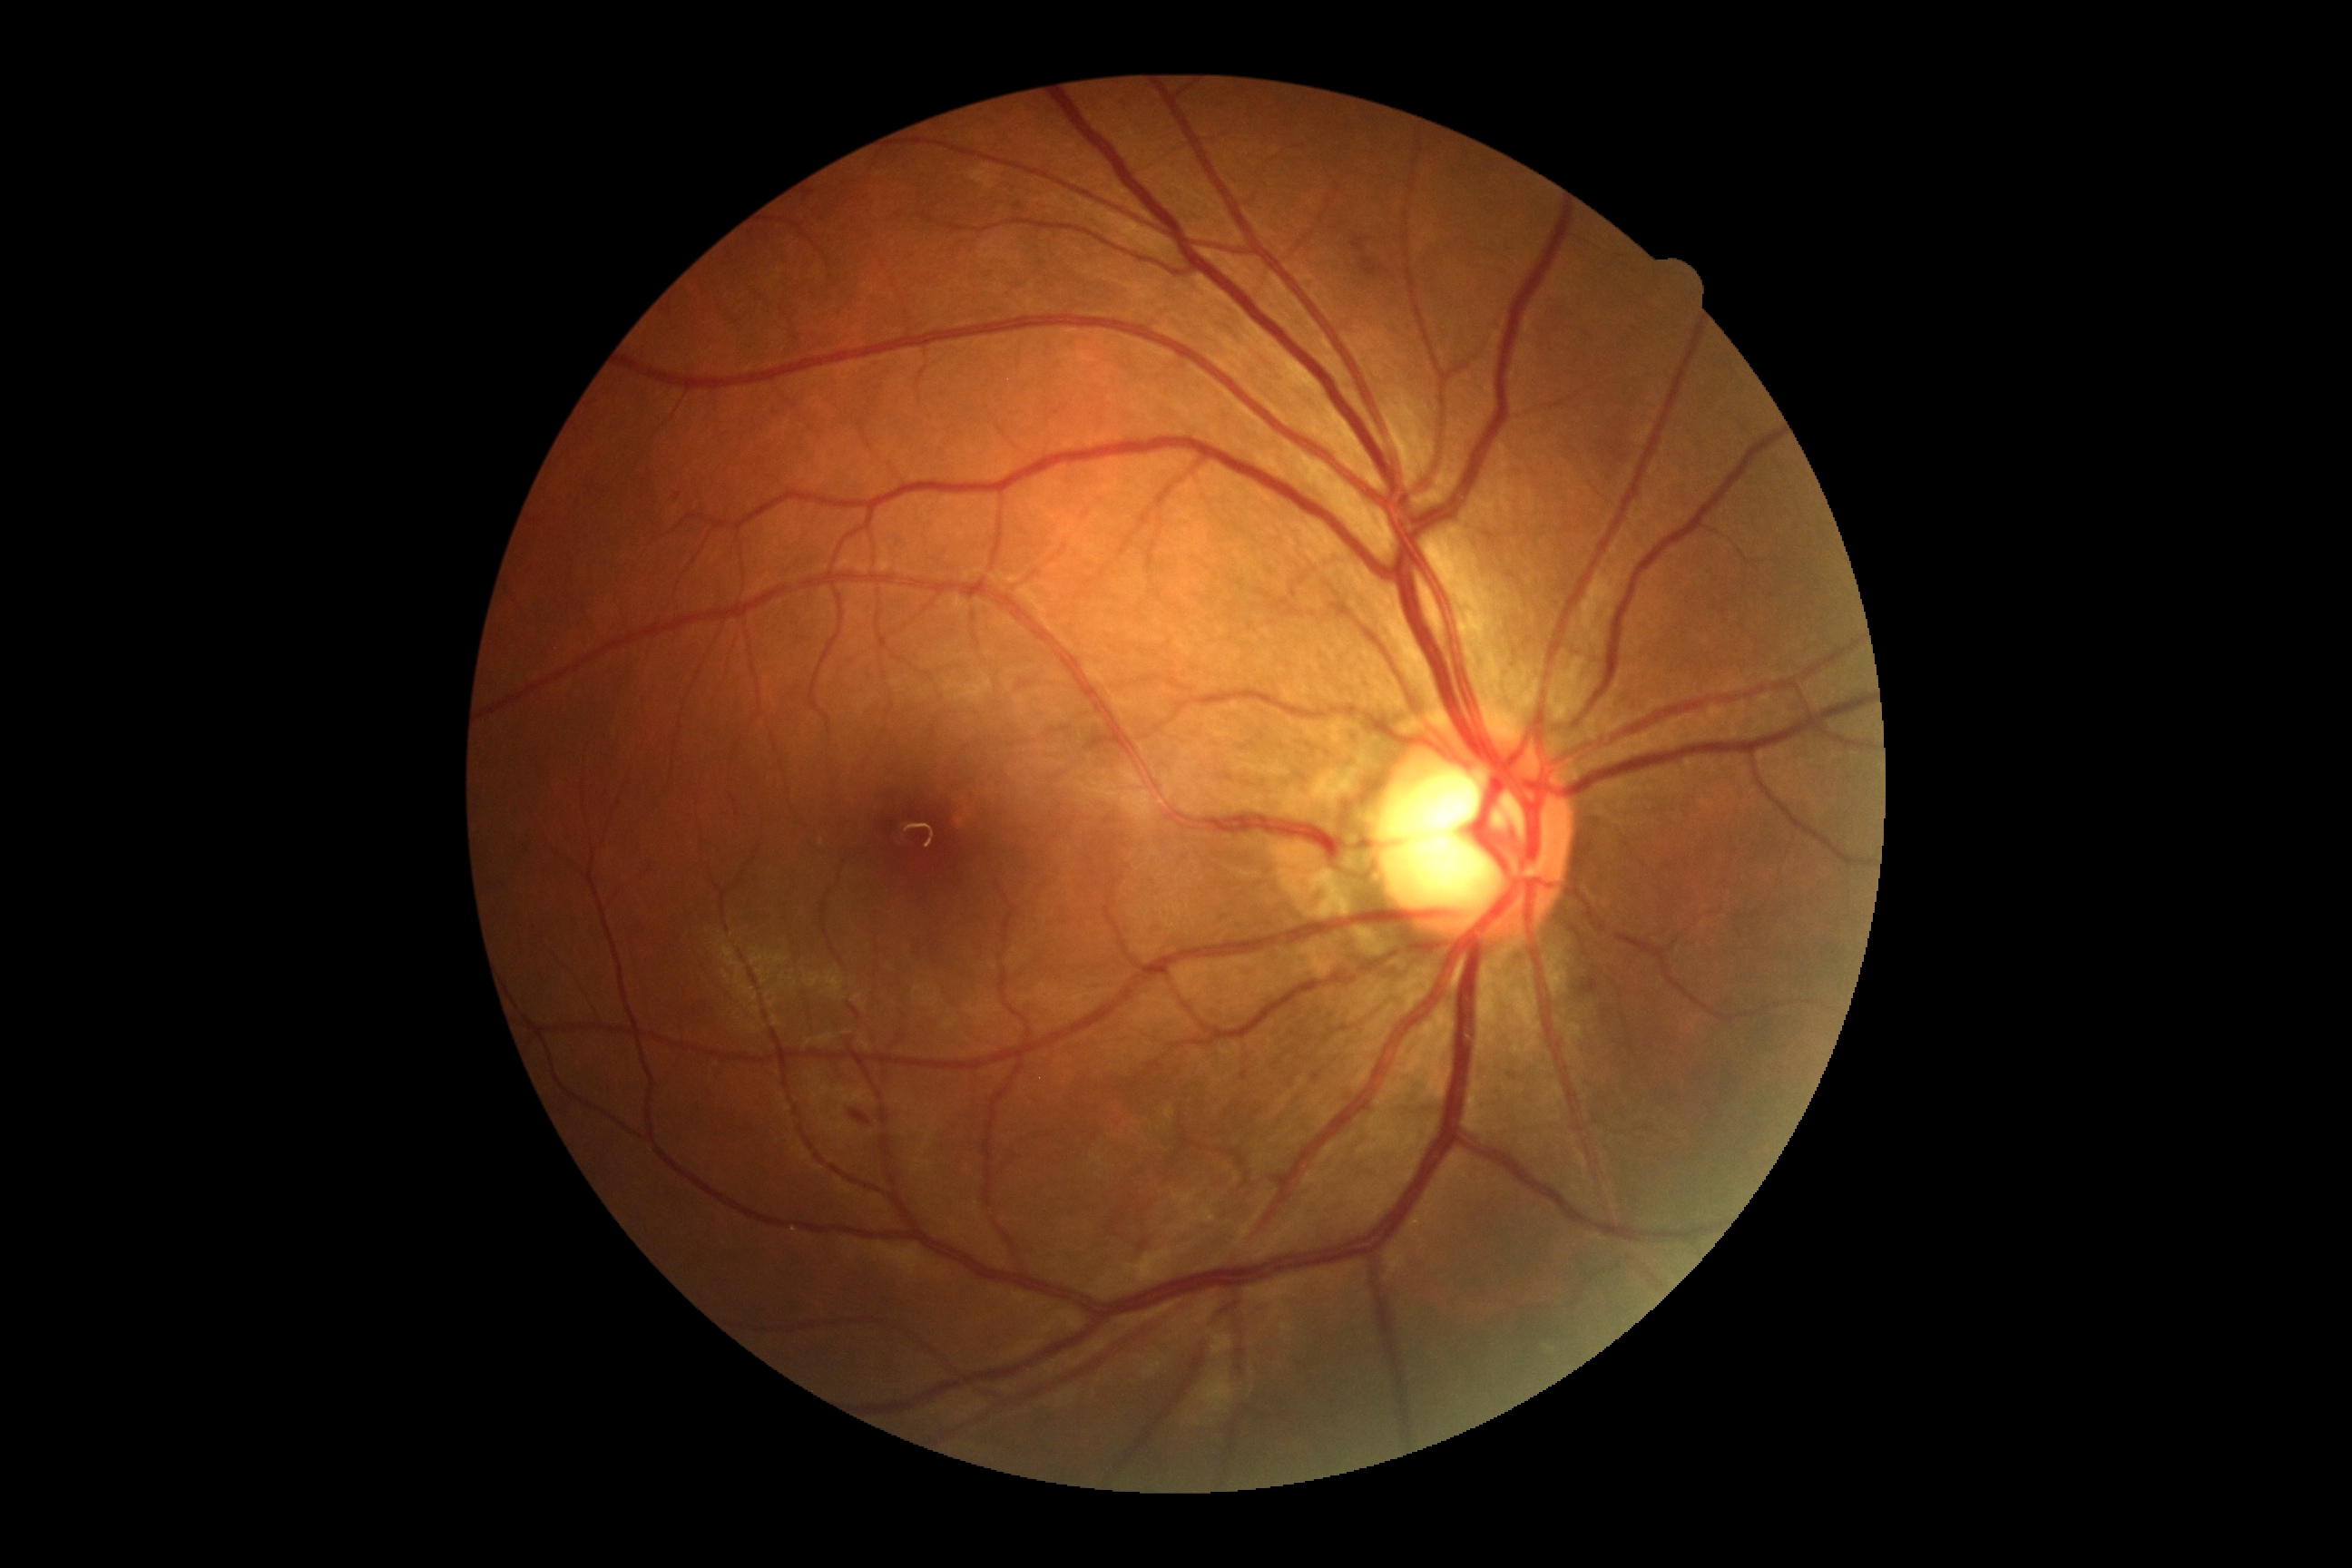

{
  "dr_grade": "moderate NPDR (grade 2)"
}